1624x1232: 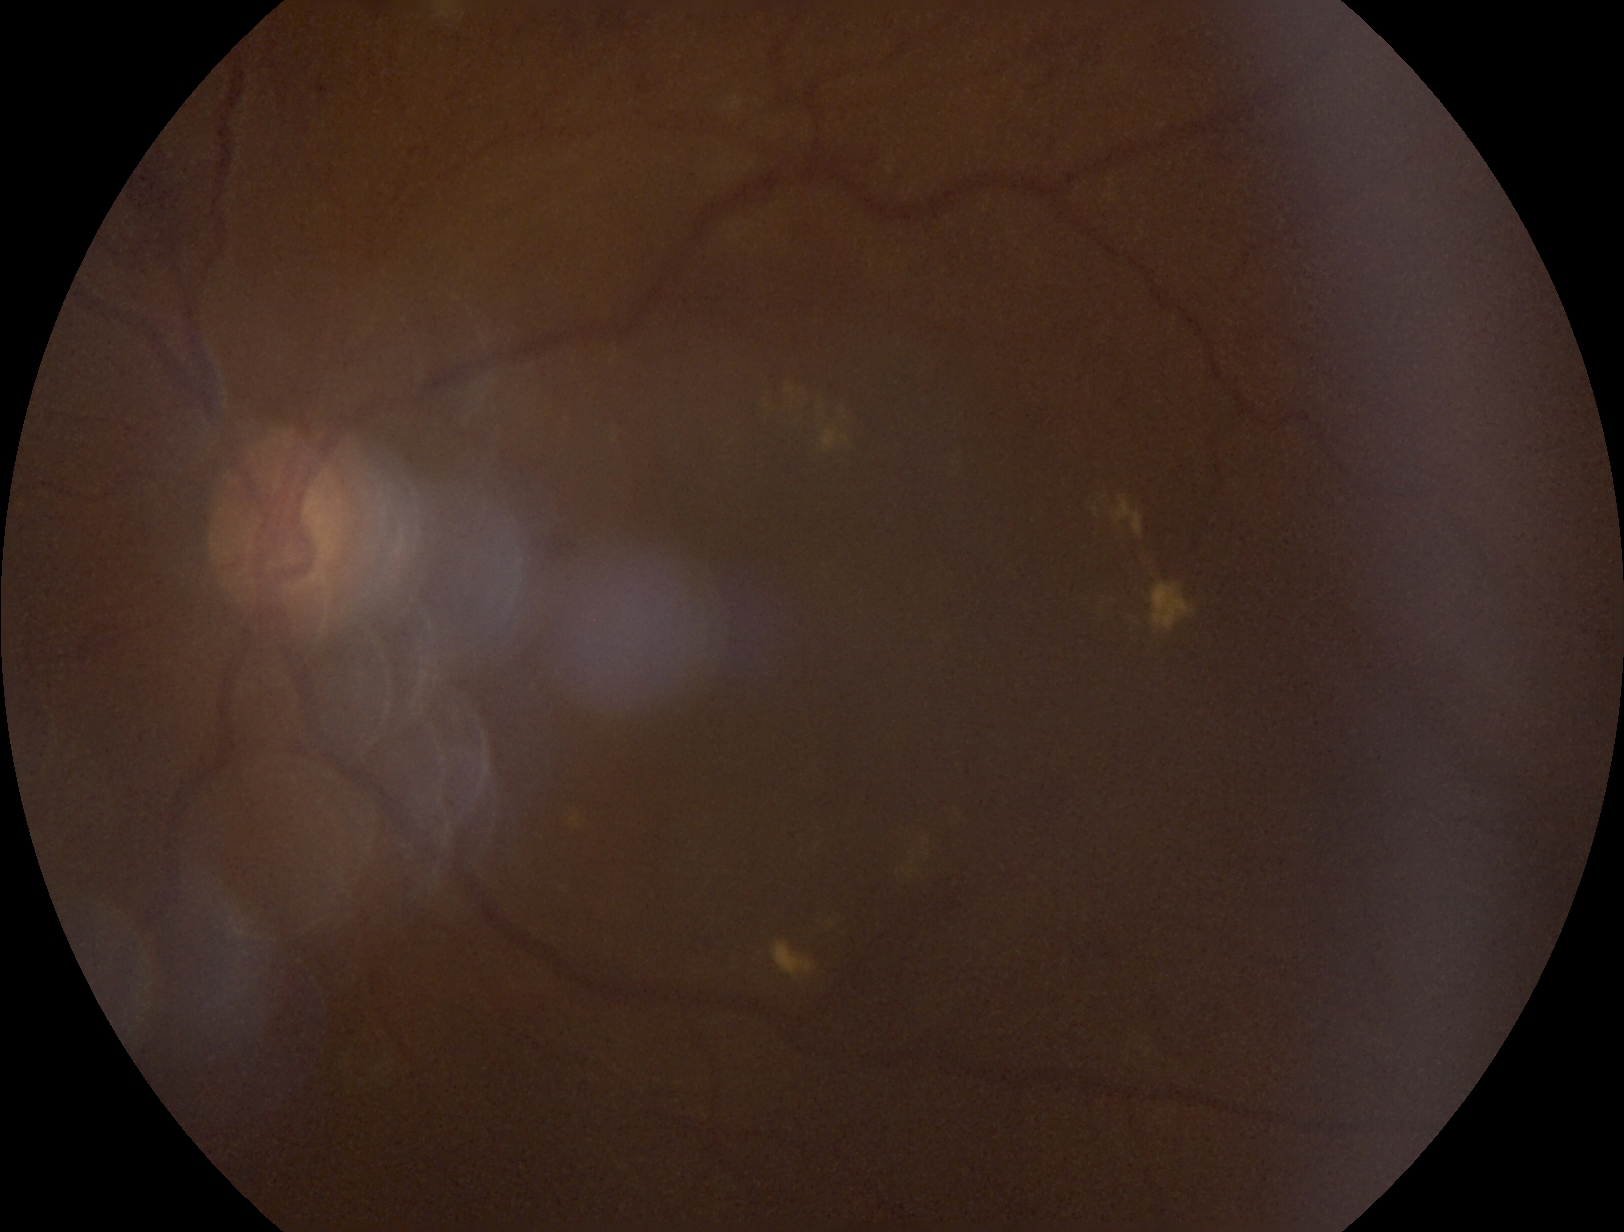 DR: grade 2 (moderate NPDR).